Fundus photo. 2212 x 1659 pixels — 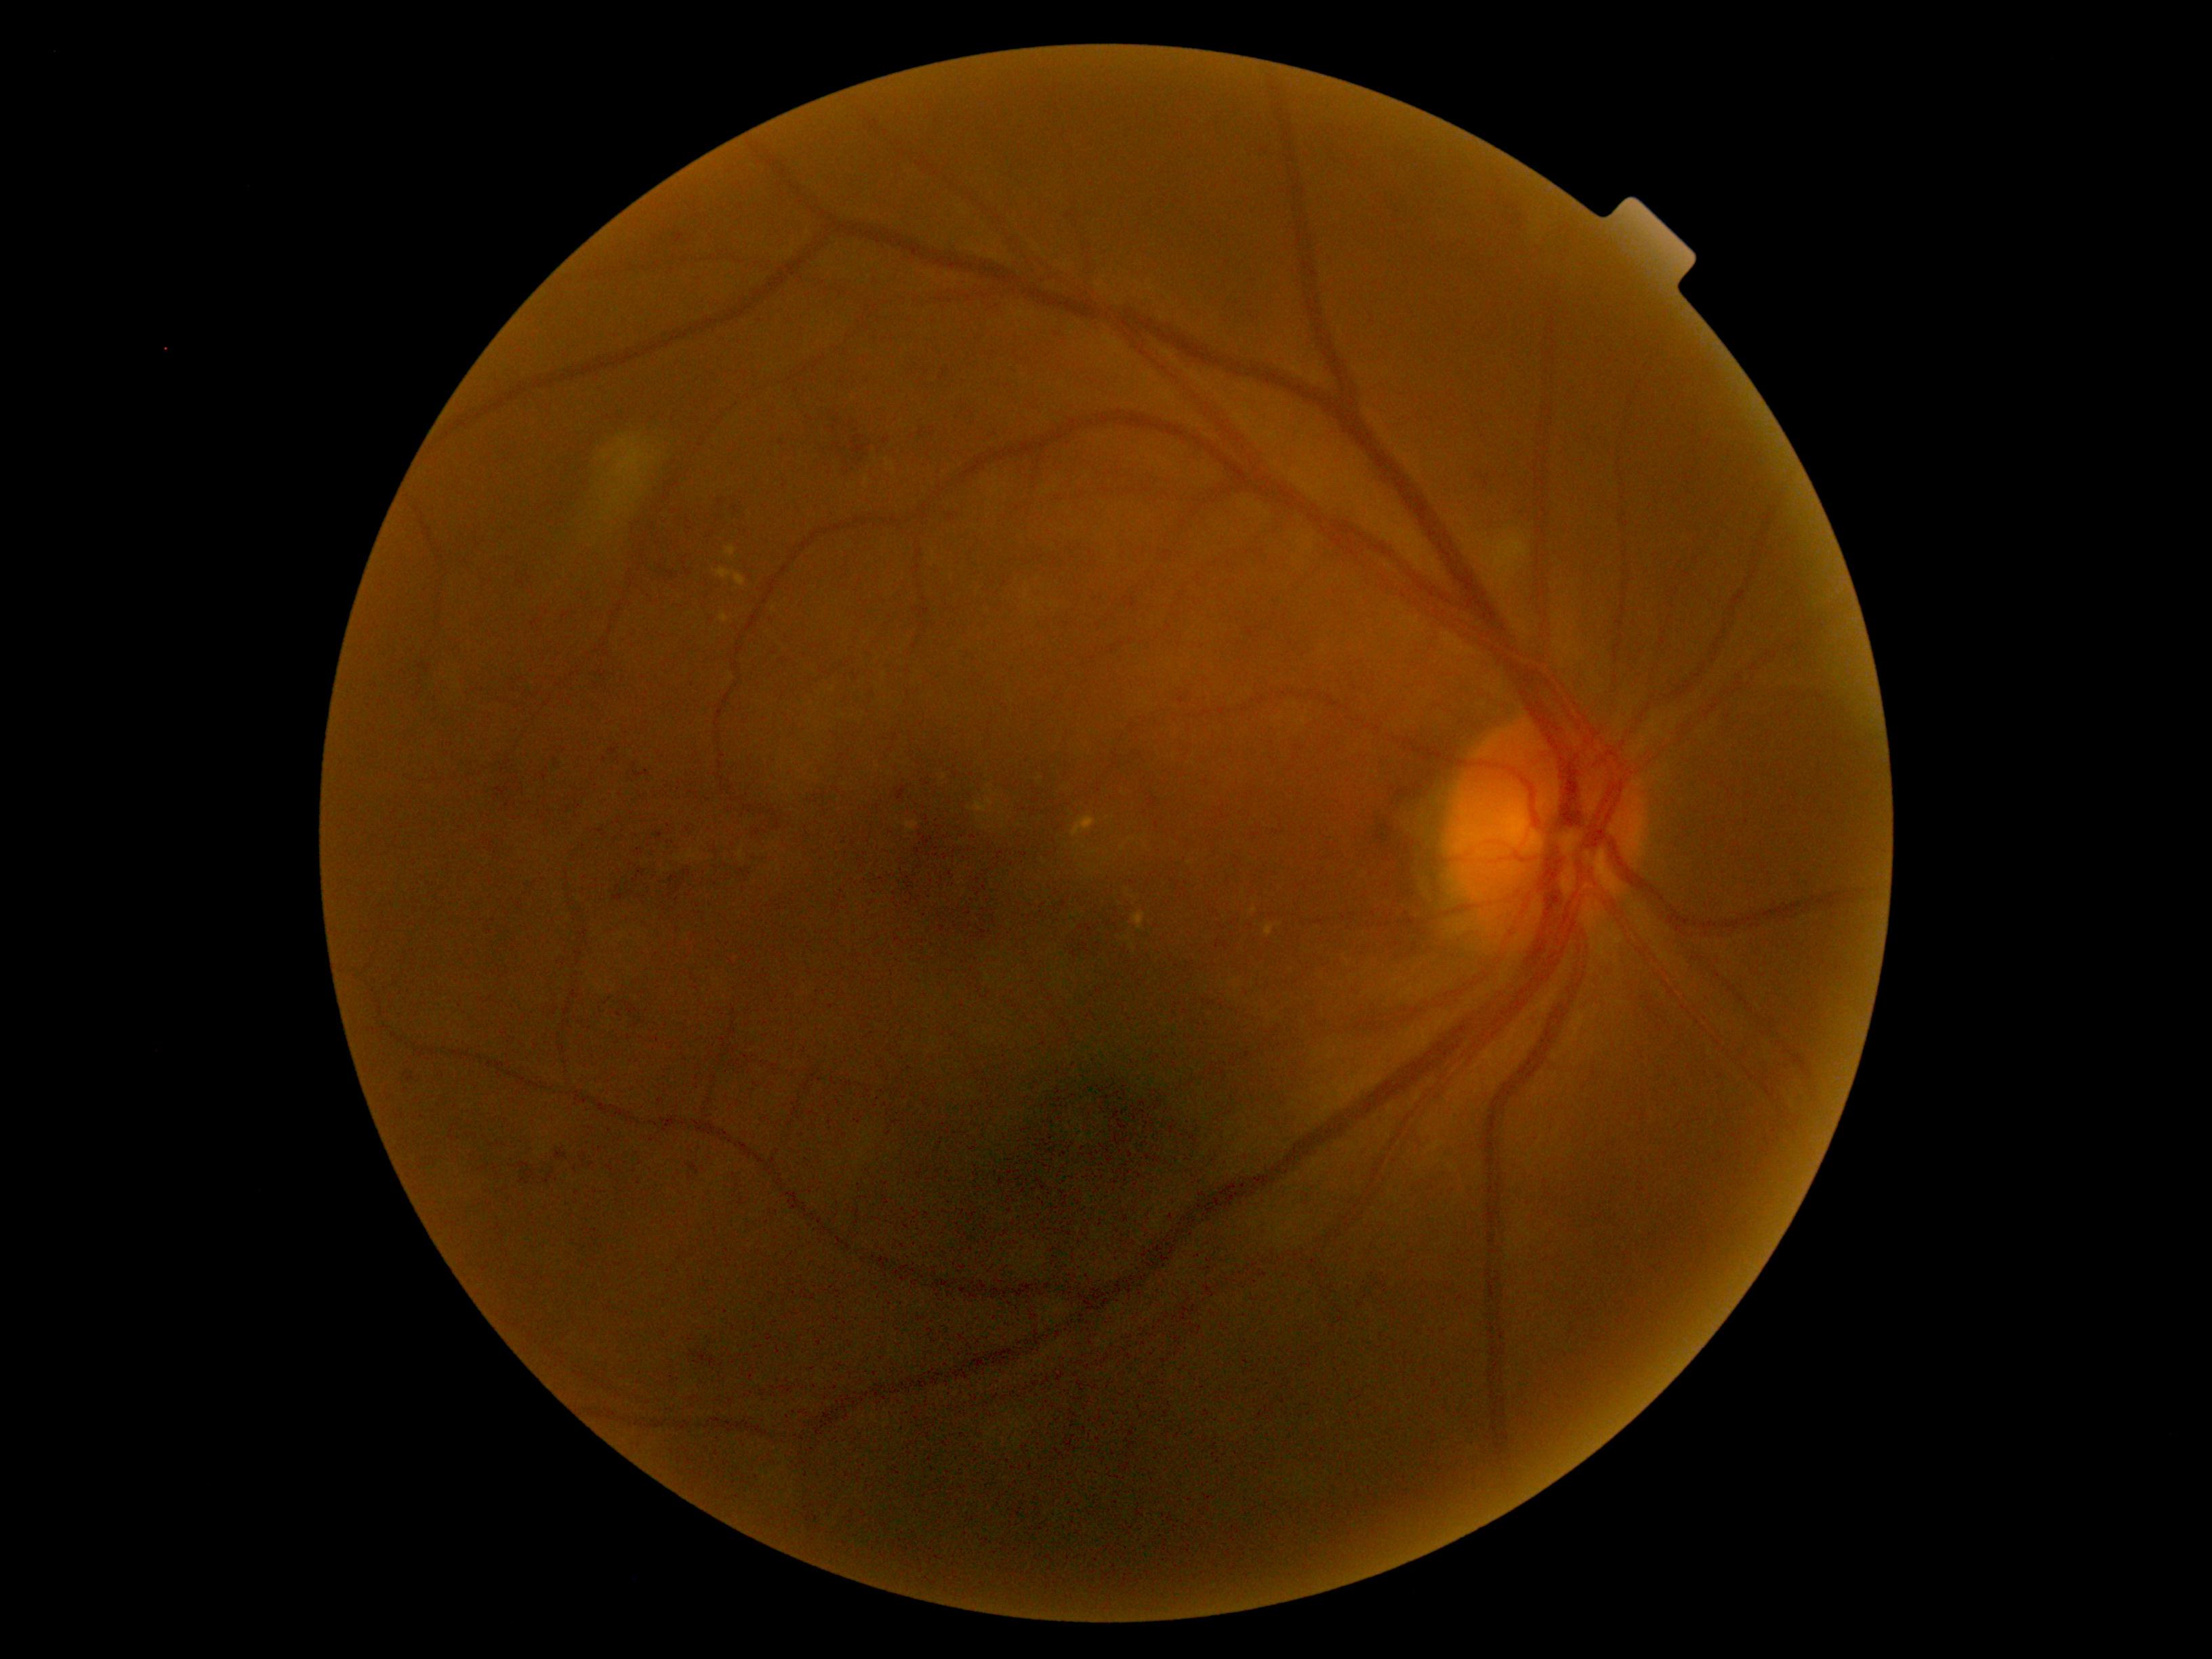 DR severity is grade 2.